848 x 848 pixels: 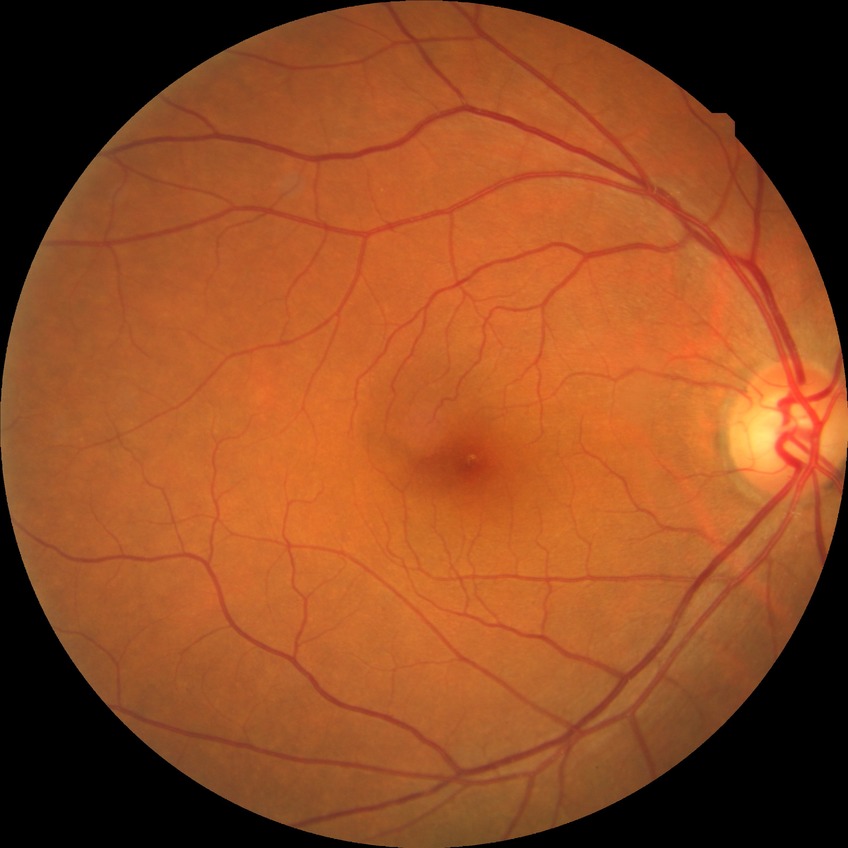

diabetic retinopathy (DR): no diabetic retinopathy (NDR)